Fundus photo · image size 2048x1536 — 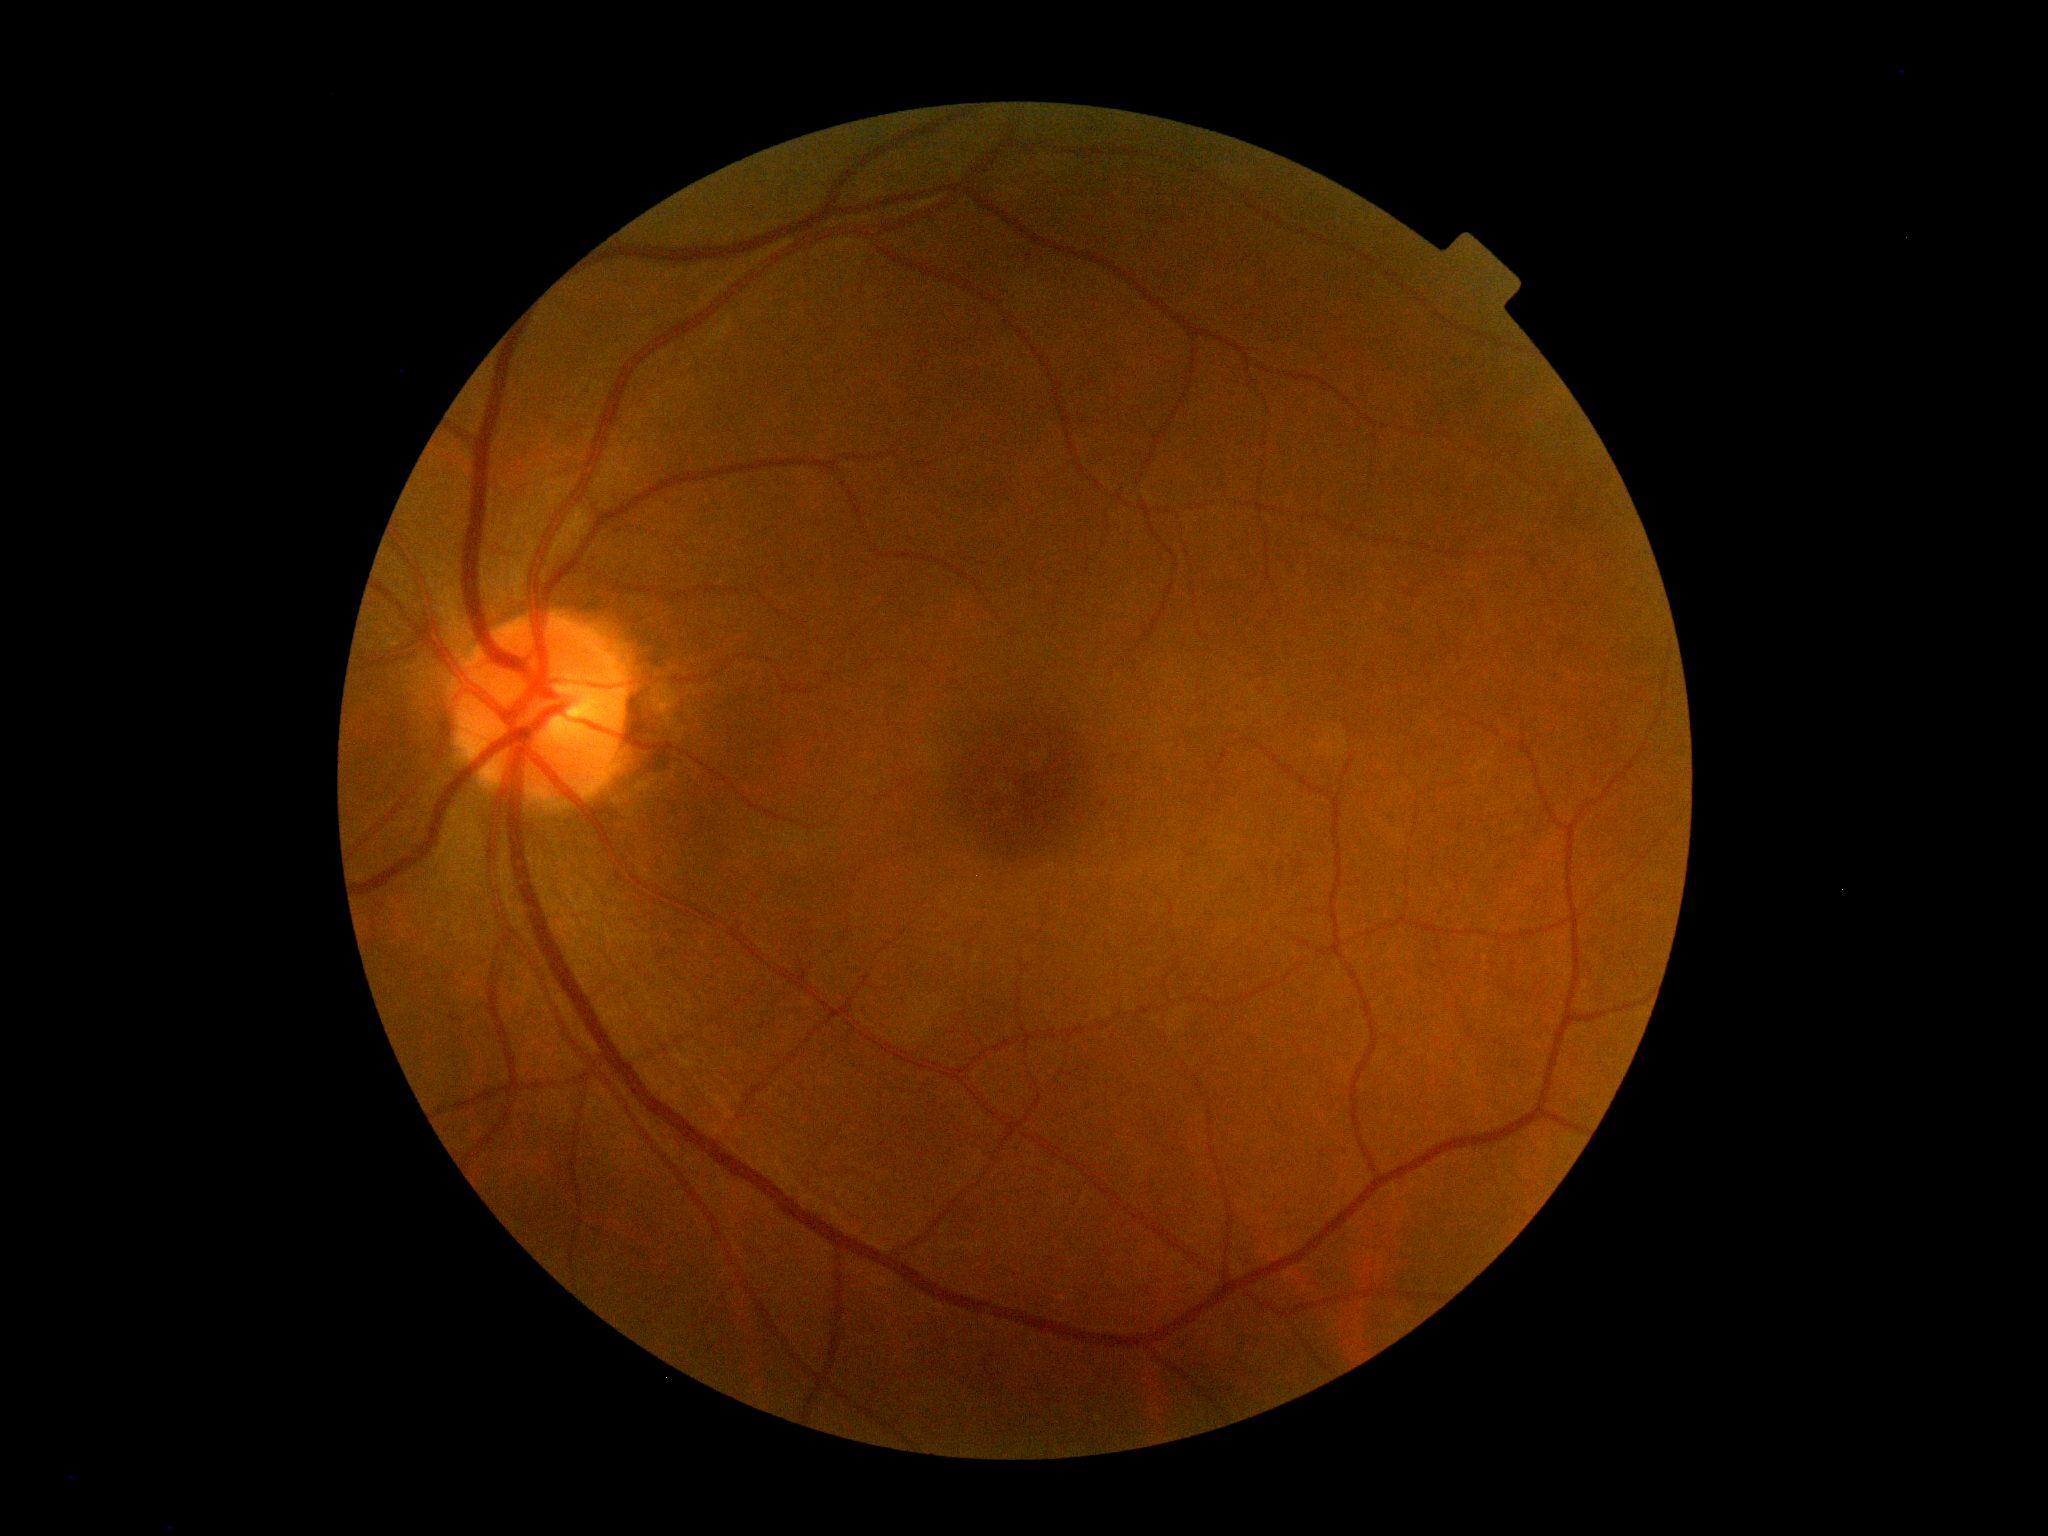
Findings:
– DR: 0/4